1659 by 2212 pixels — 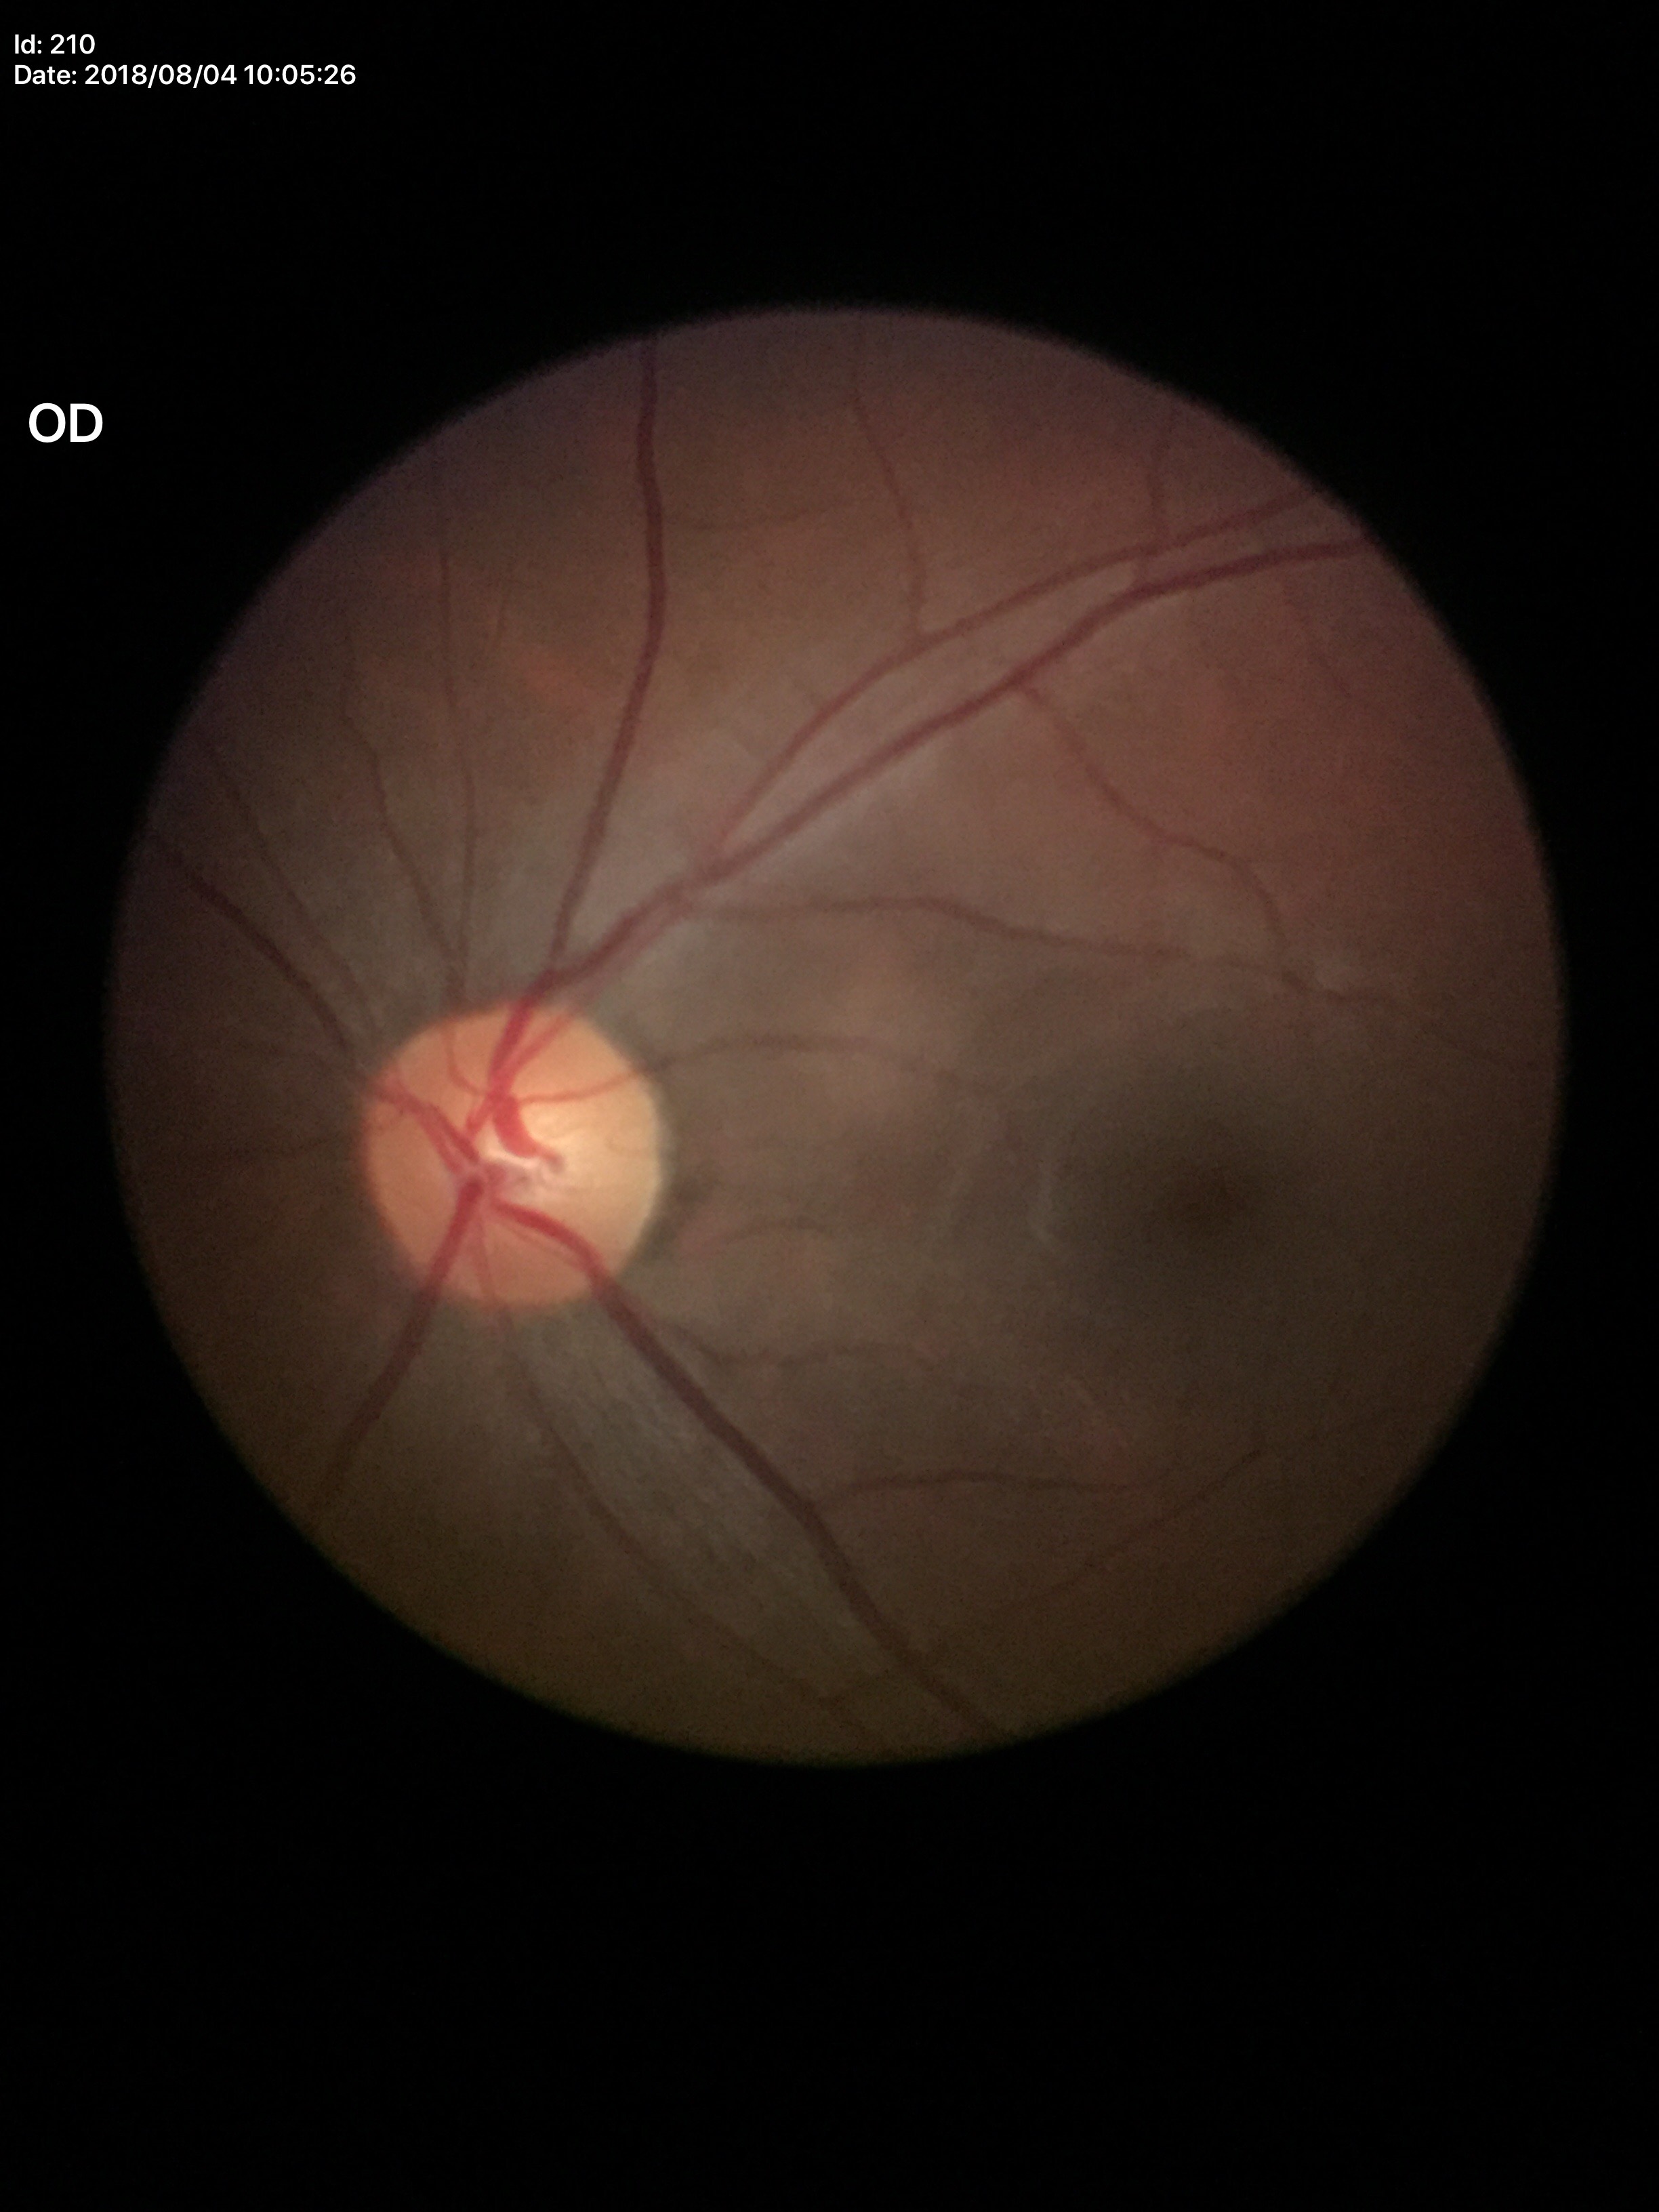
Q: What is the glaucoma assessment?
A: no suspicious findings
Q: Vertical CDR?
A: 0.52